Color fundus photograph.
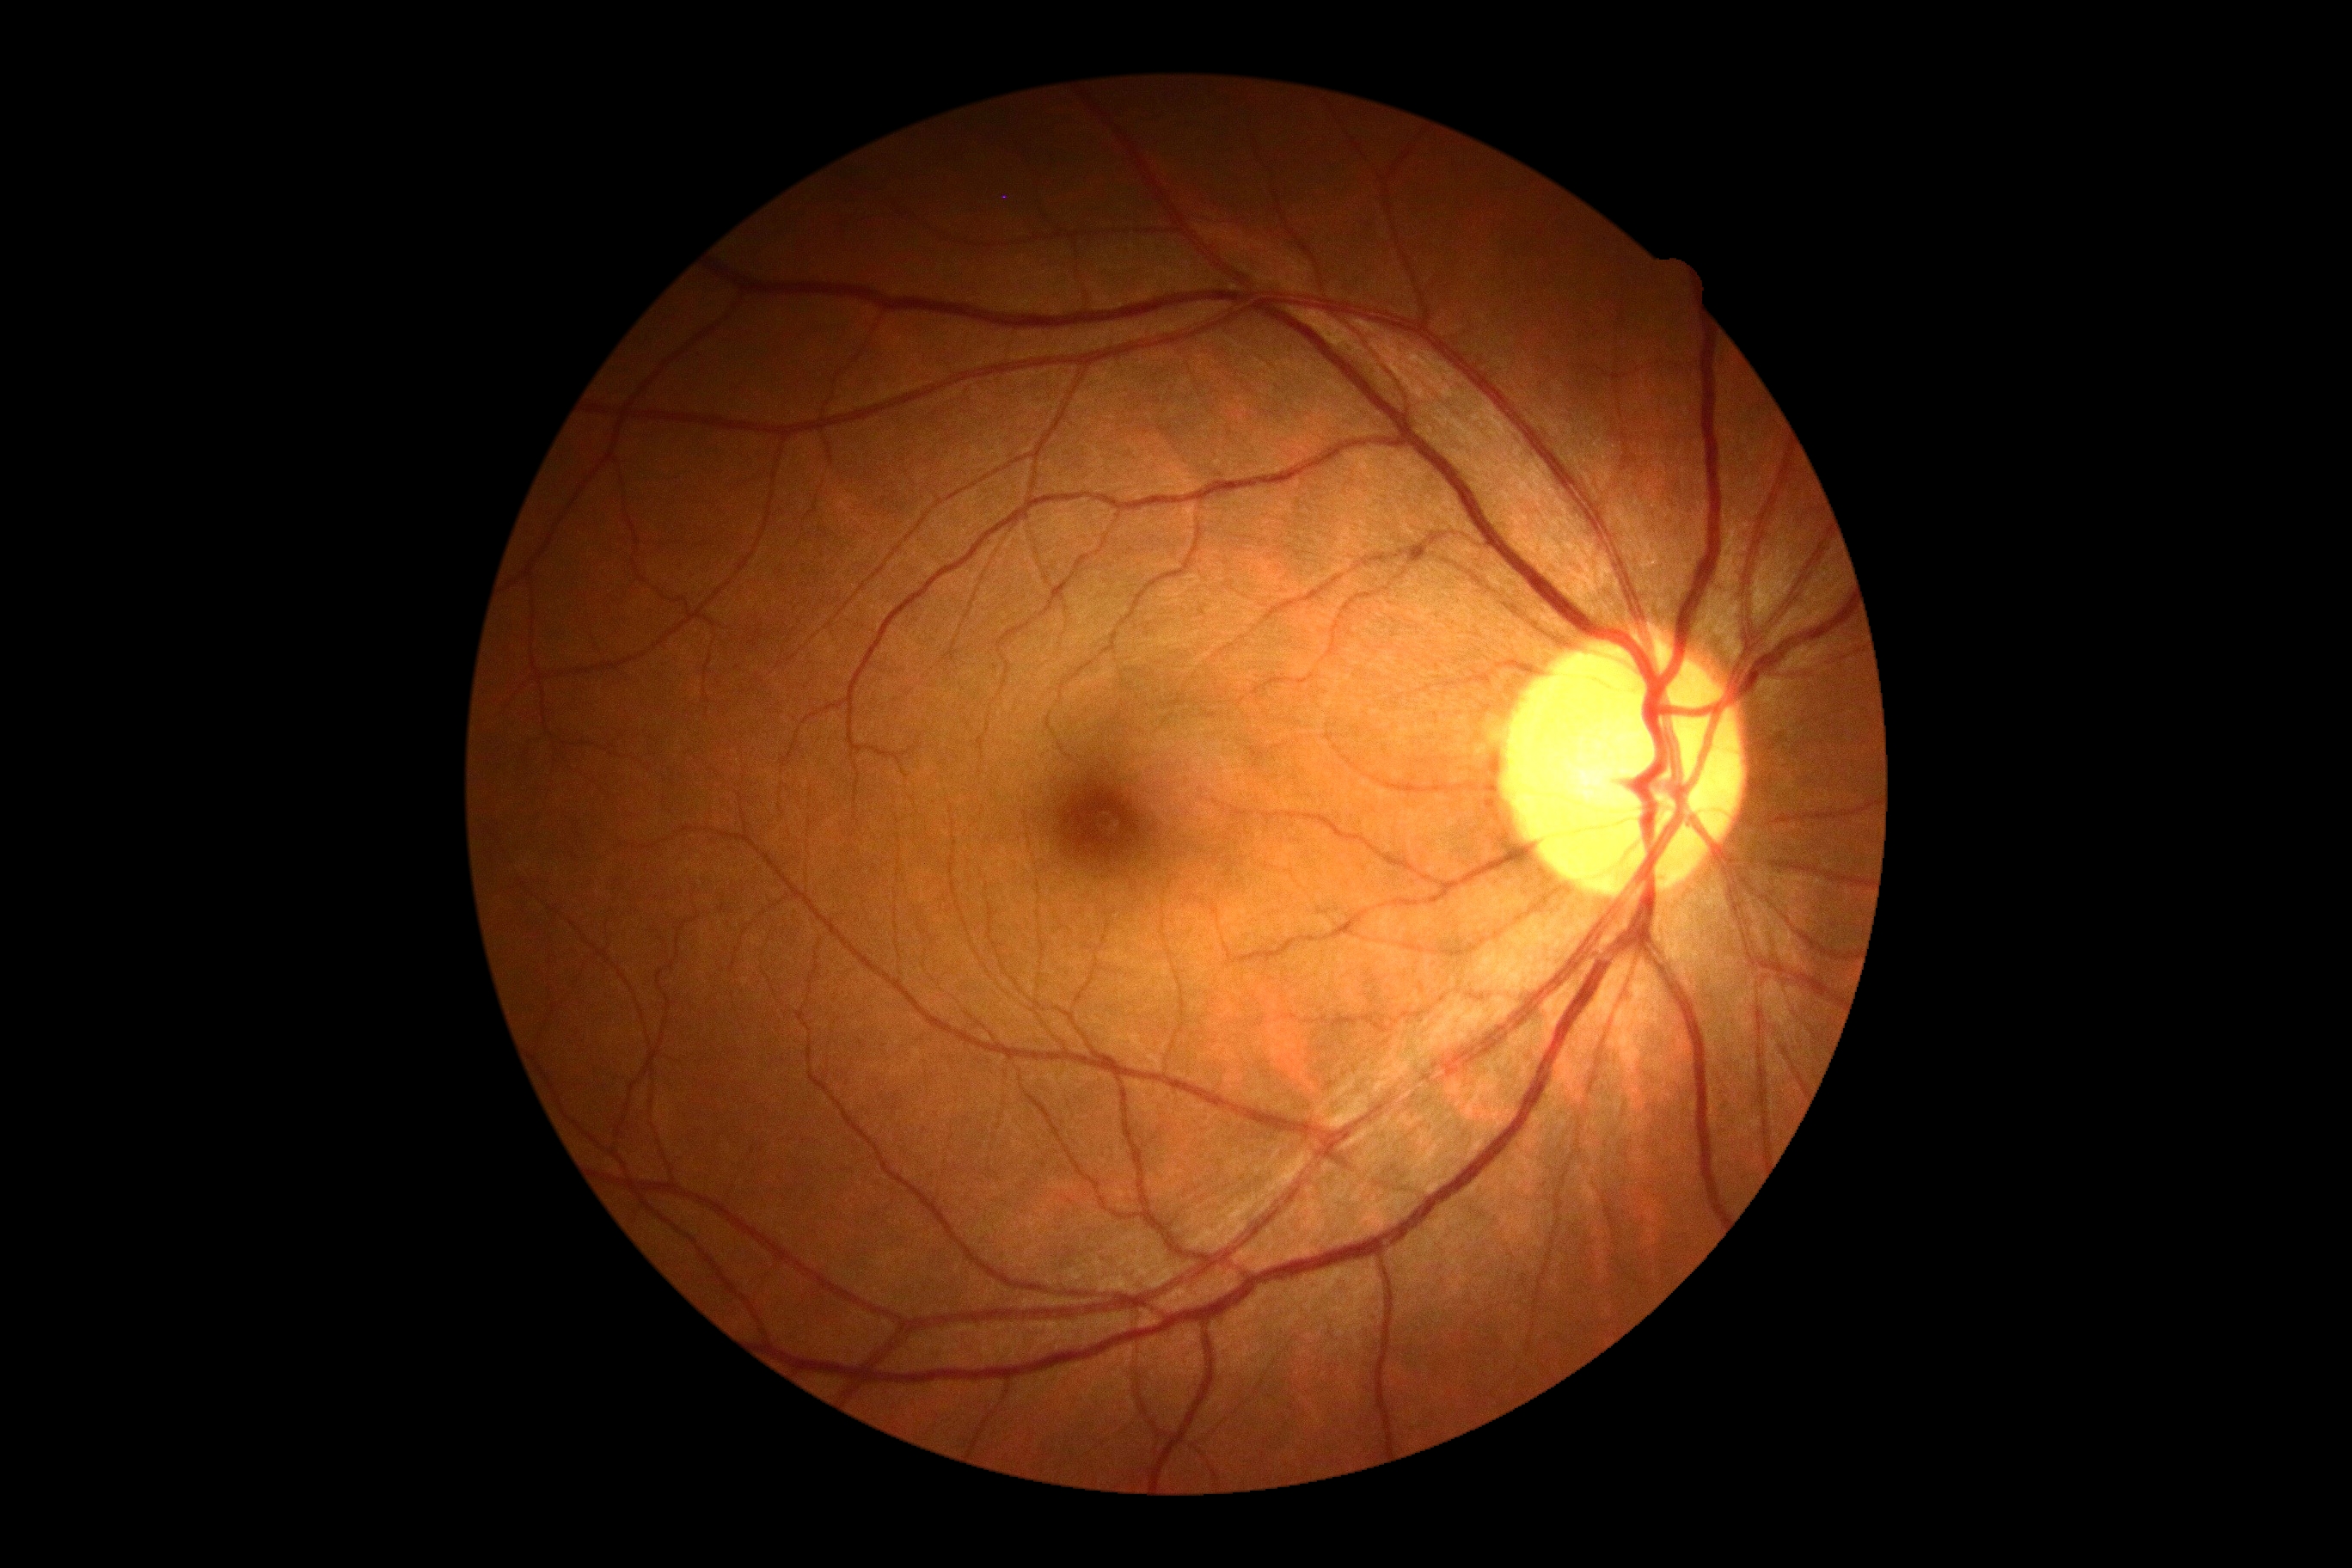 Diabetic retinopathy (DR) is grade 0 (no apparent retinopathy).